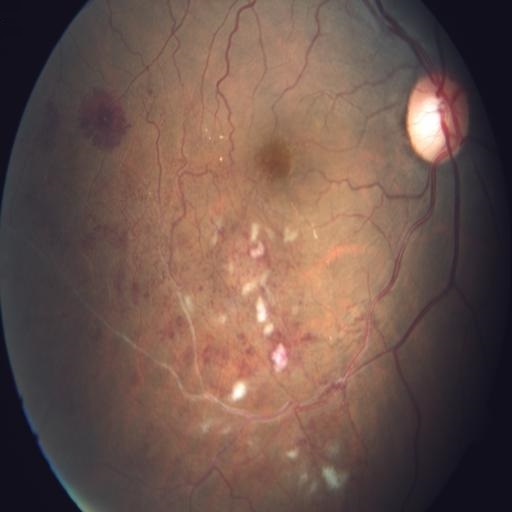

Abnormalities: CWS (cotton wool spots); BRVO (branch retinal vein occlusion).